Davis DR grading, posterior pole photograph, without pupil dilation:
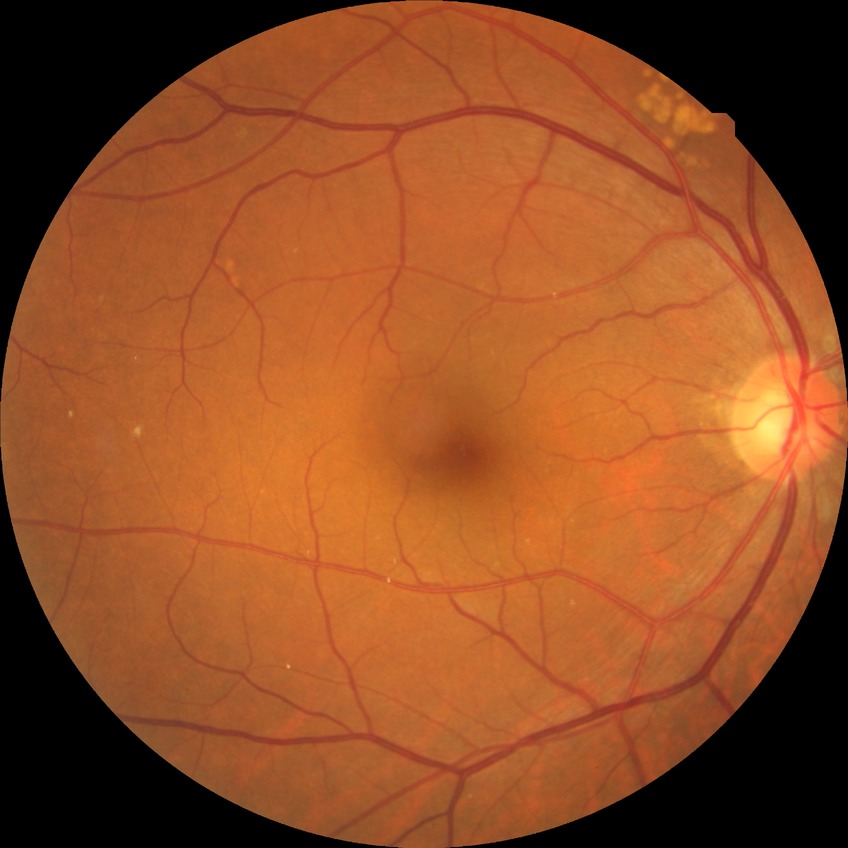

Davis DR grade: NDR.